Diabetic retinopathy graded by the modified Davis classification: 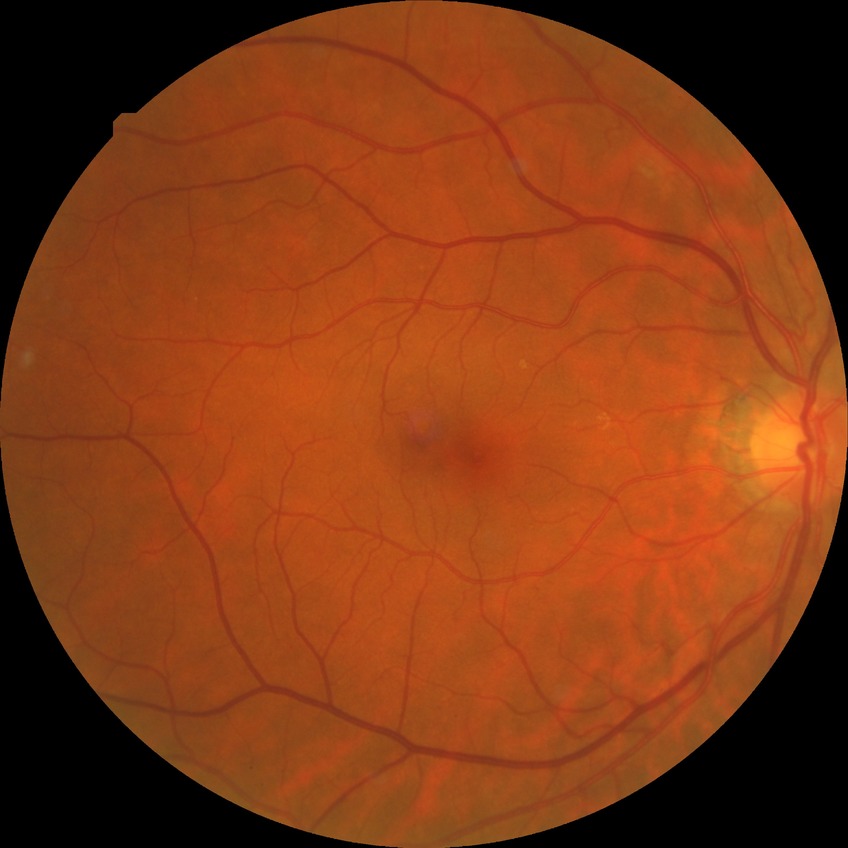

Diabetic retinopathy (DR) is NDR (no diabetic retinopathy).